Color fundus image. Camera: Remidio Fundus on Phone (FOP) camera:
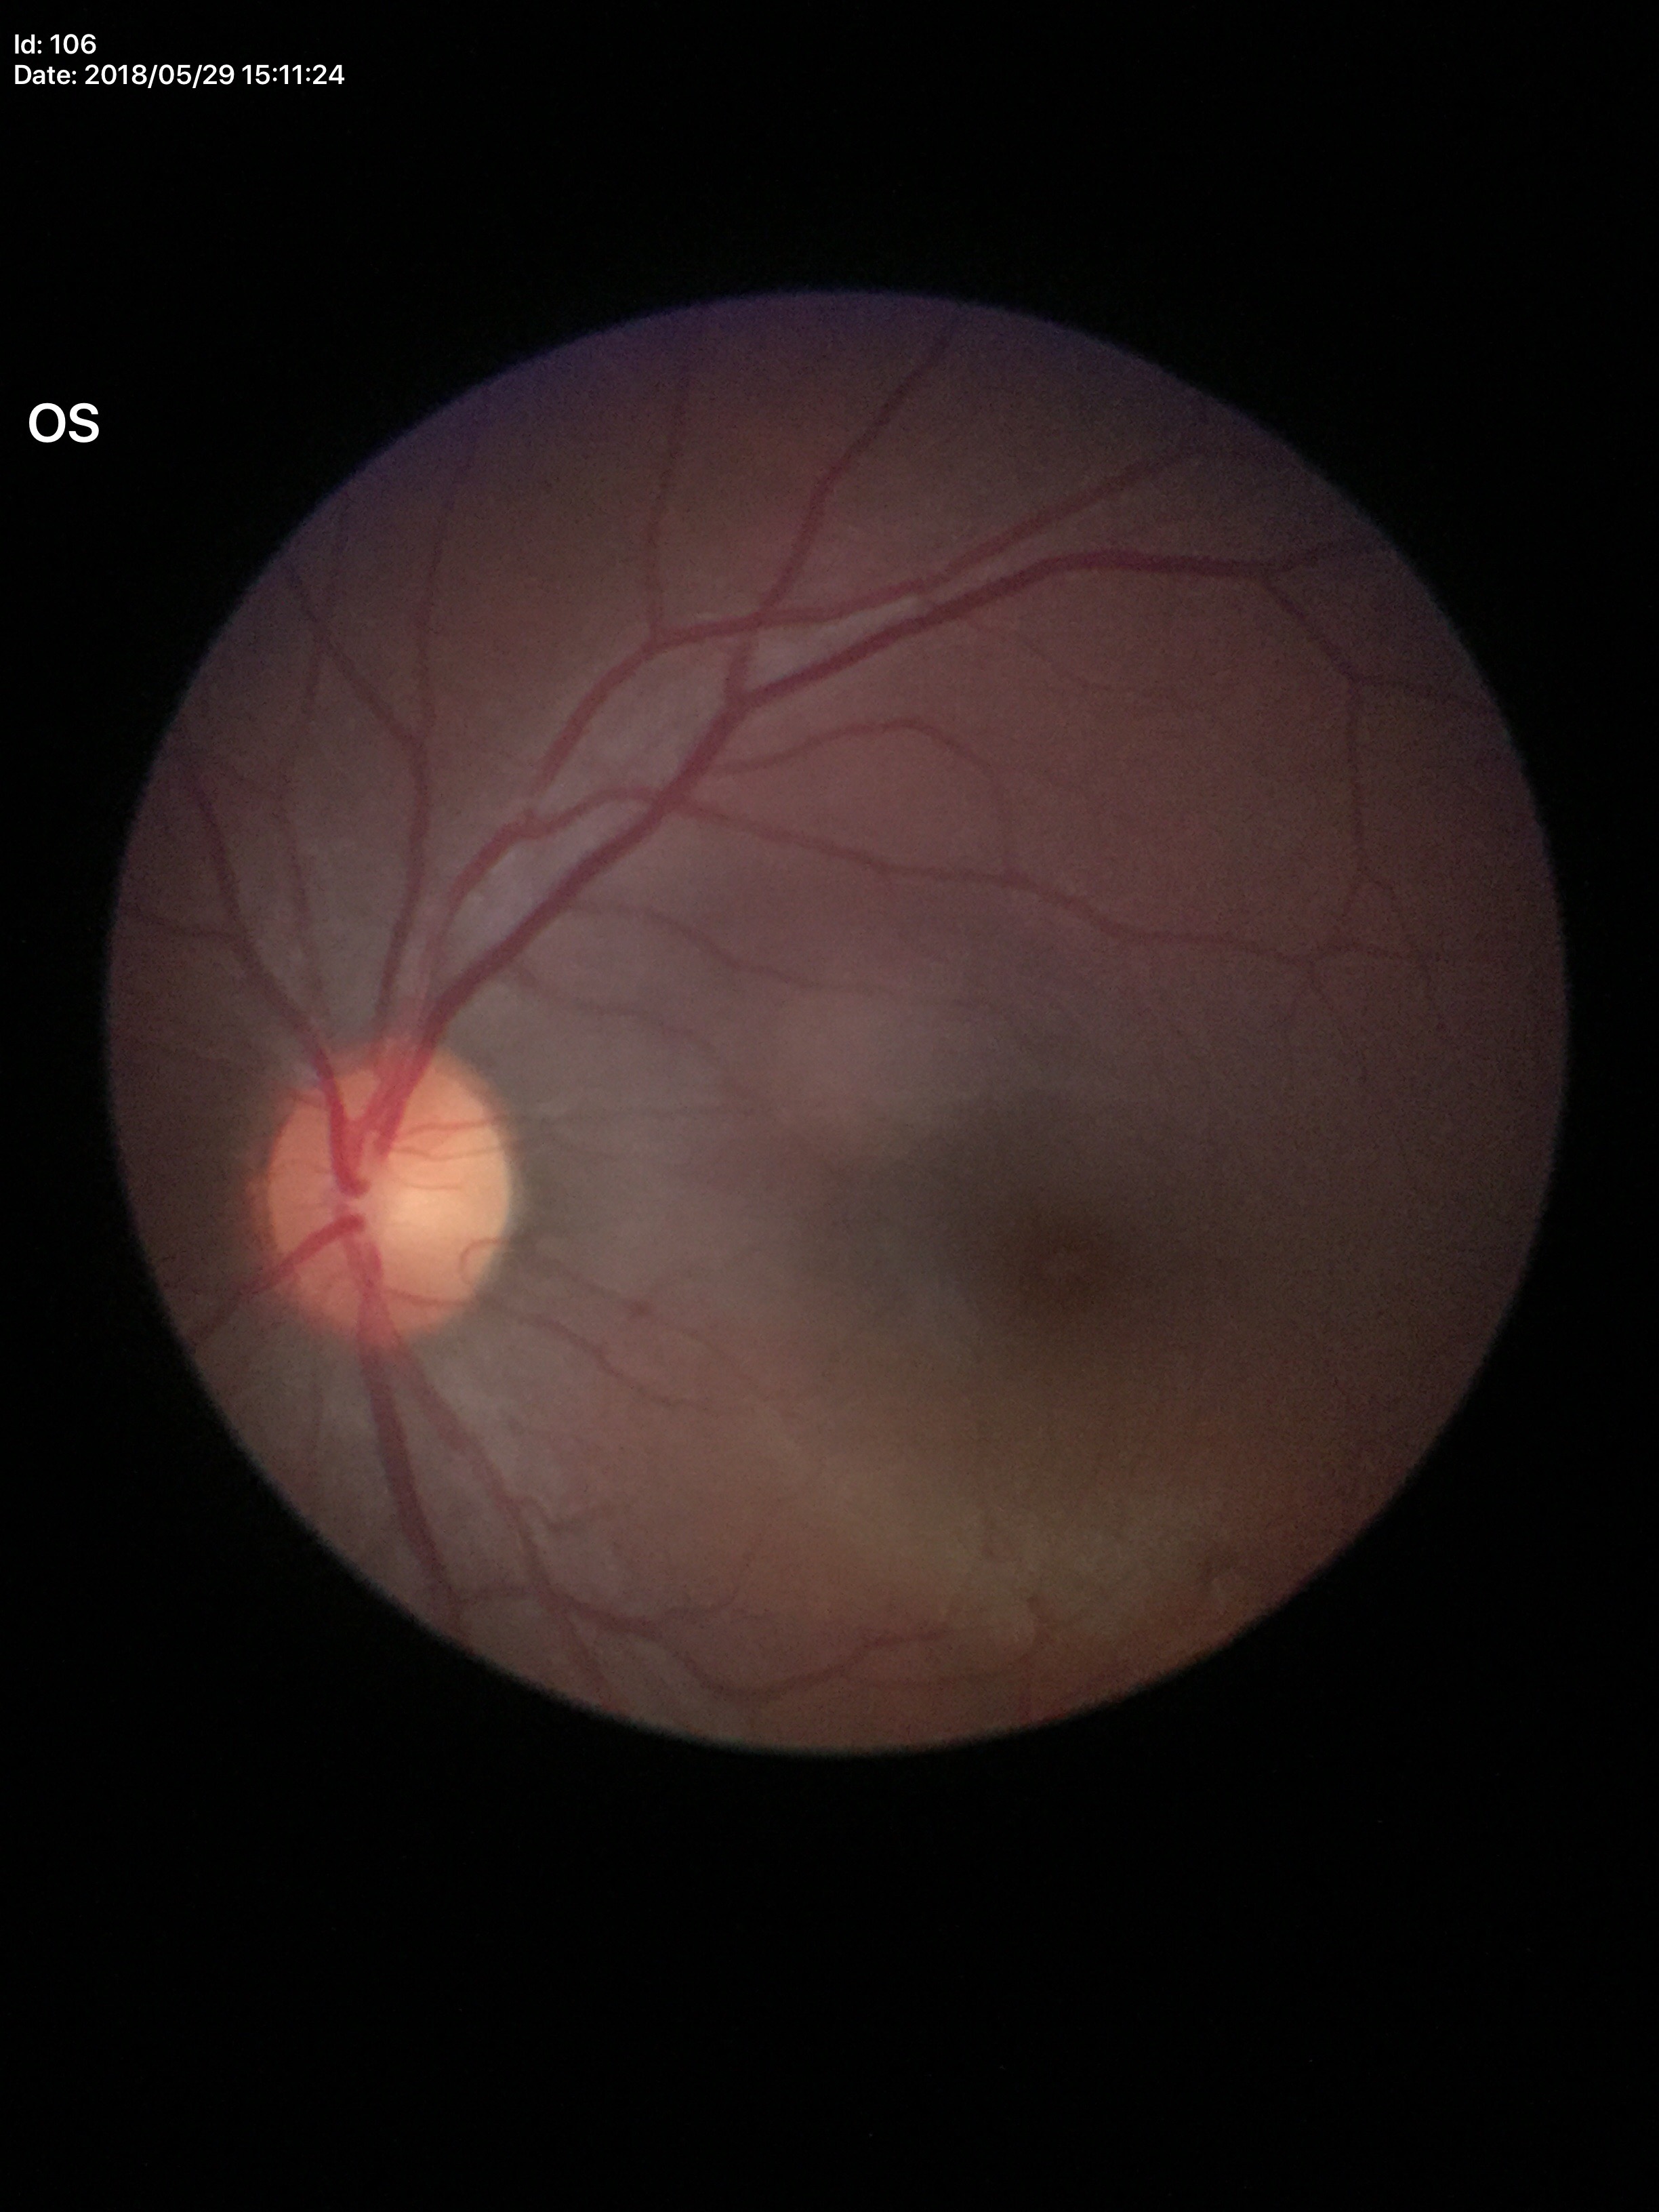

Glaucoma assessment: no suspicious findings. Horizontal cup-to-disc ratio (HCDR) is 0.51. Vertical cup-disc ratio (VCDR): 0.52.